848x848px; 45° field of view
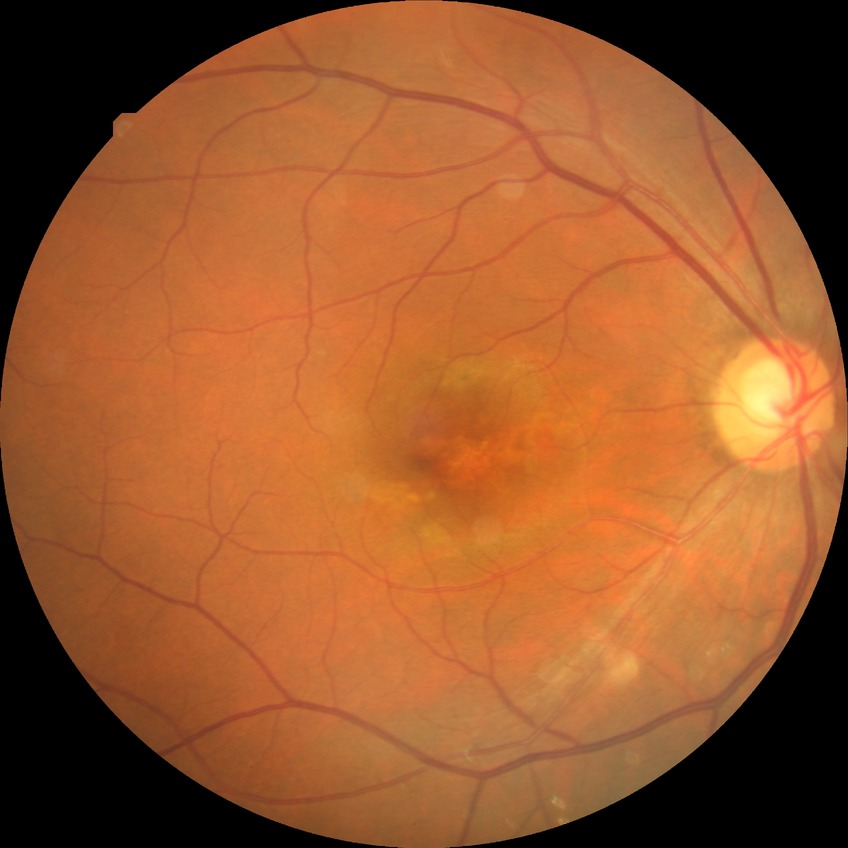 Modified Davis classification: no diabetic retinopathy.